NIDEK AFC-230, color fundus image, 848x848px, 45-degree field of view, no pharmacologic dilation, DR severity per modified Davis staging: 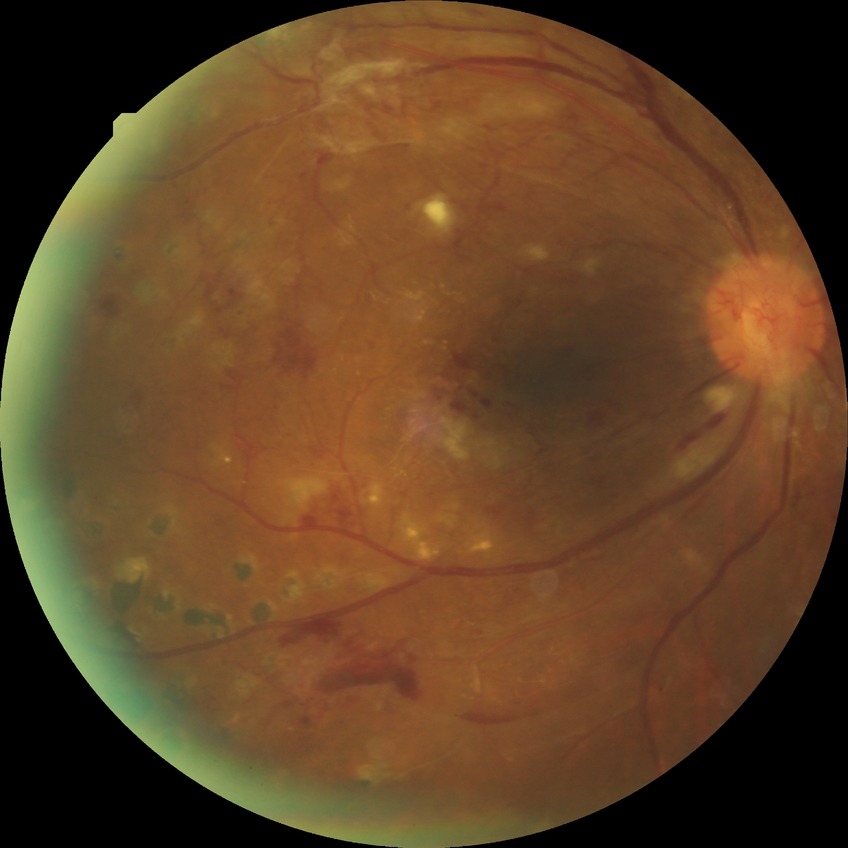
Diabetic retinopathy grade is proliferative diabetic retinopathy.